Infant wide-field fundus photograph
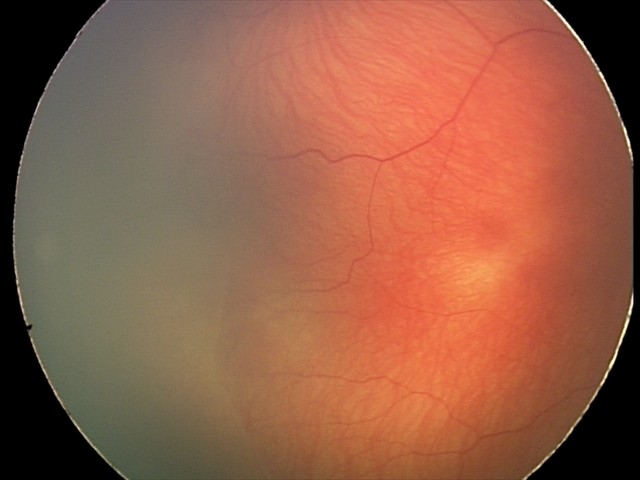 Screening examination consistent with retinopathy of prematurity stage 2 — ridge with height and width at the demarcation line. Without plus disease.